Image size 2212x1672: 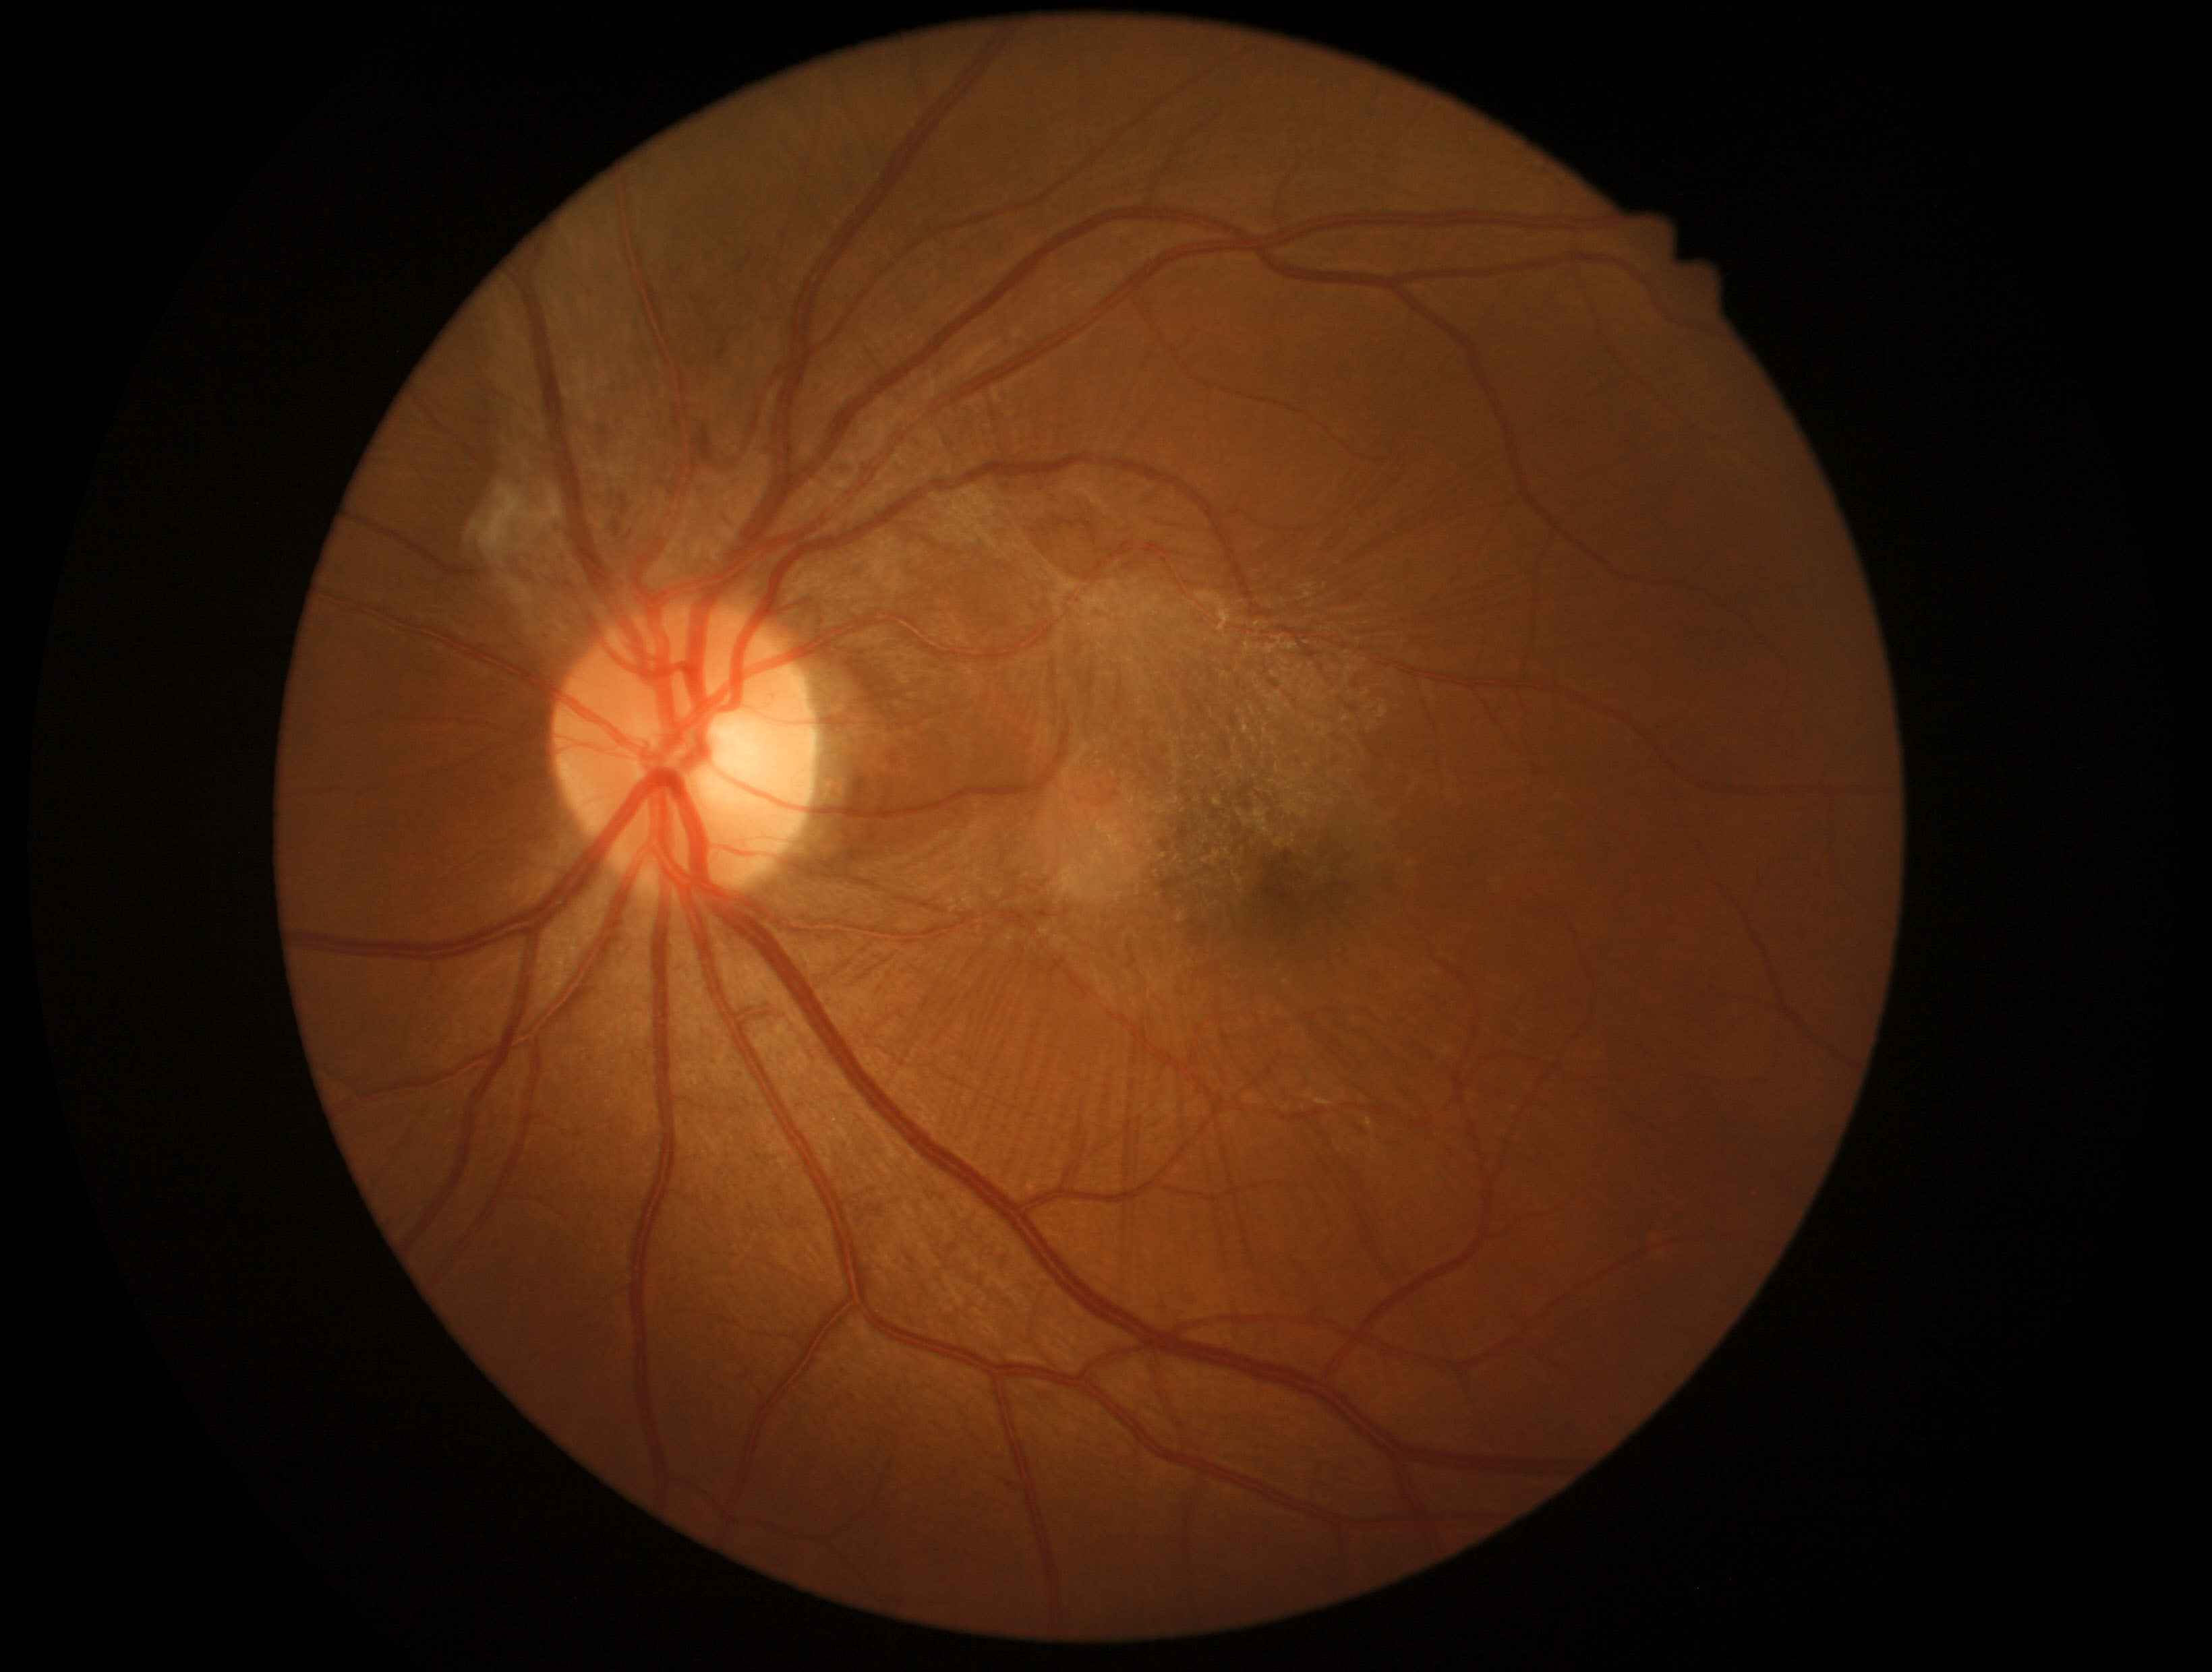

Disease class: proliferative diabetic retinopathy.
DR severity: grade 4.